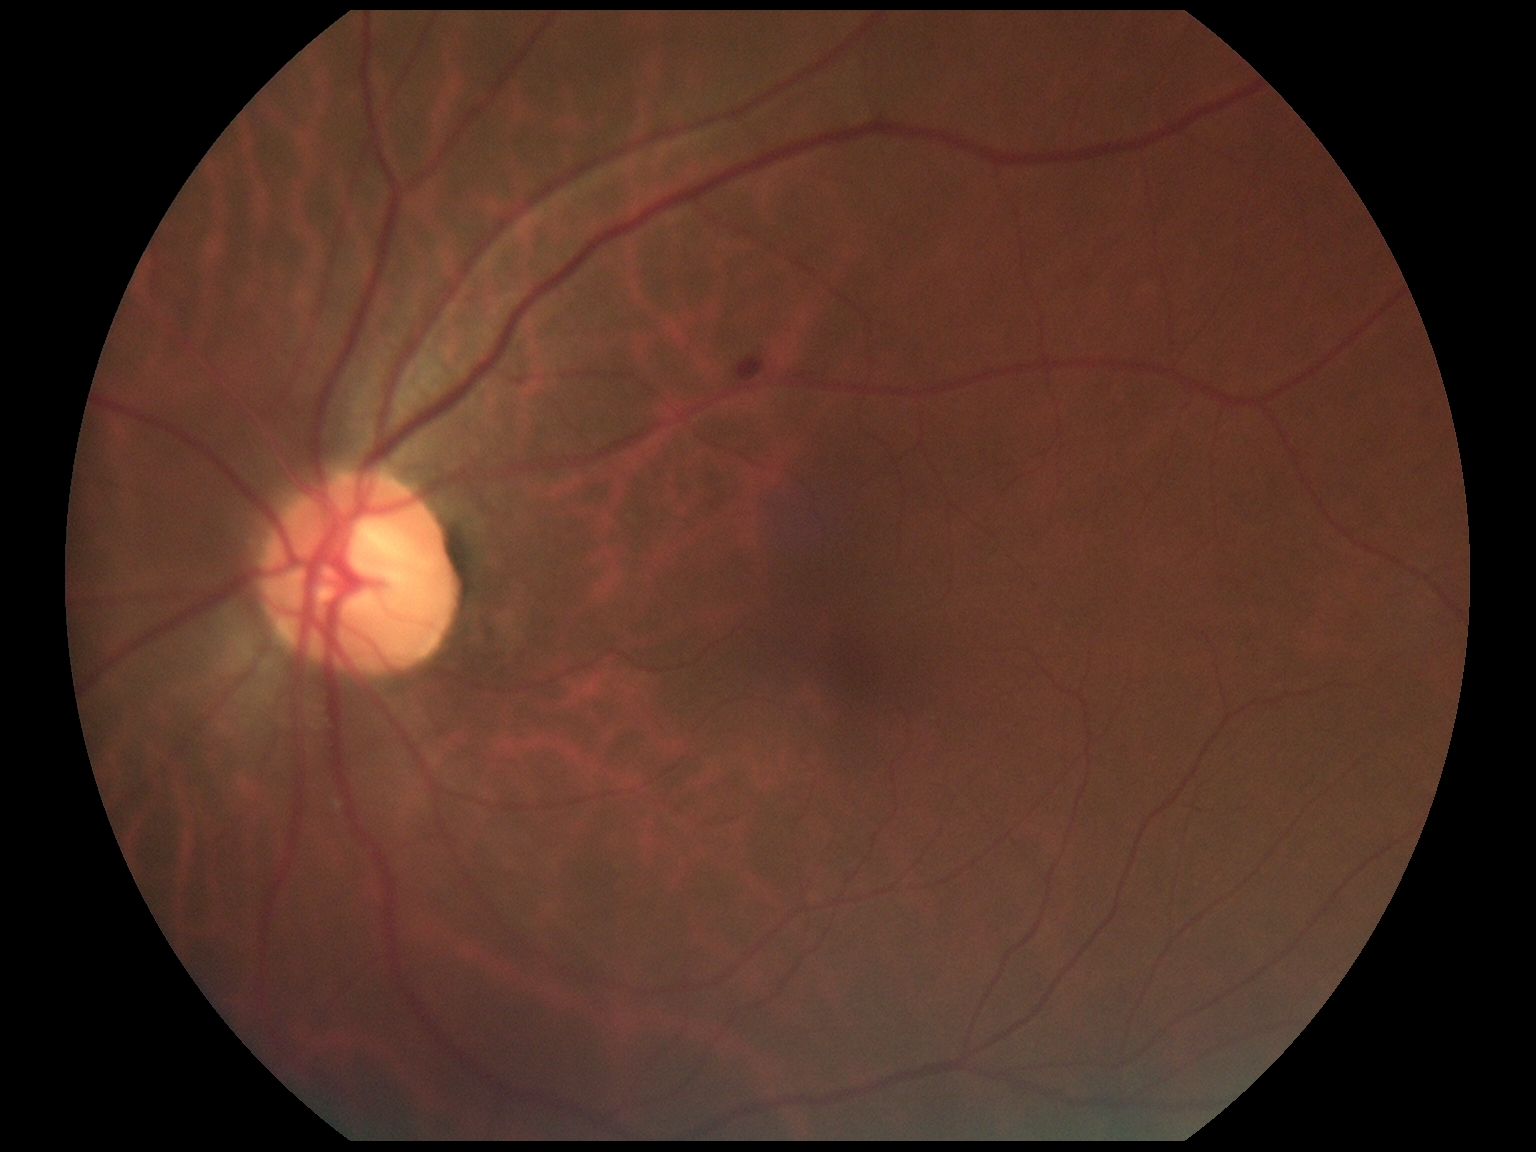
DR class: non-proliferative diabetic retinopathy. Retinopathy is moderate non-proliferative diabetic retinopathy (grade 2).